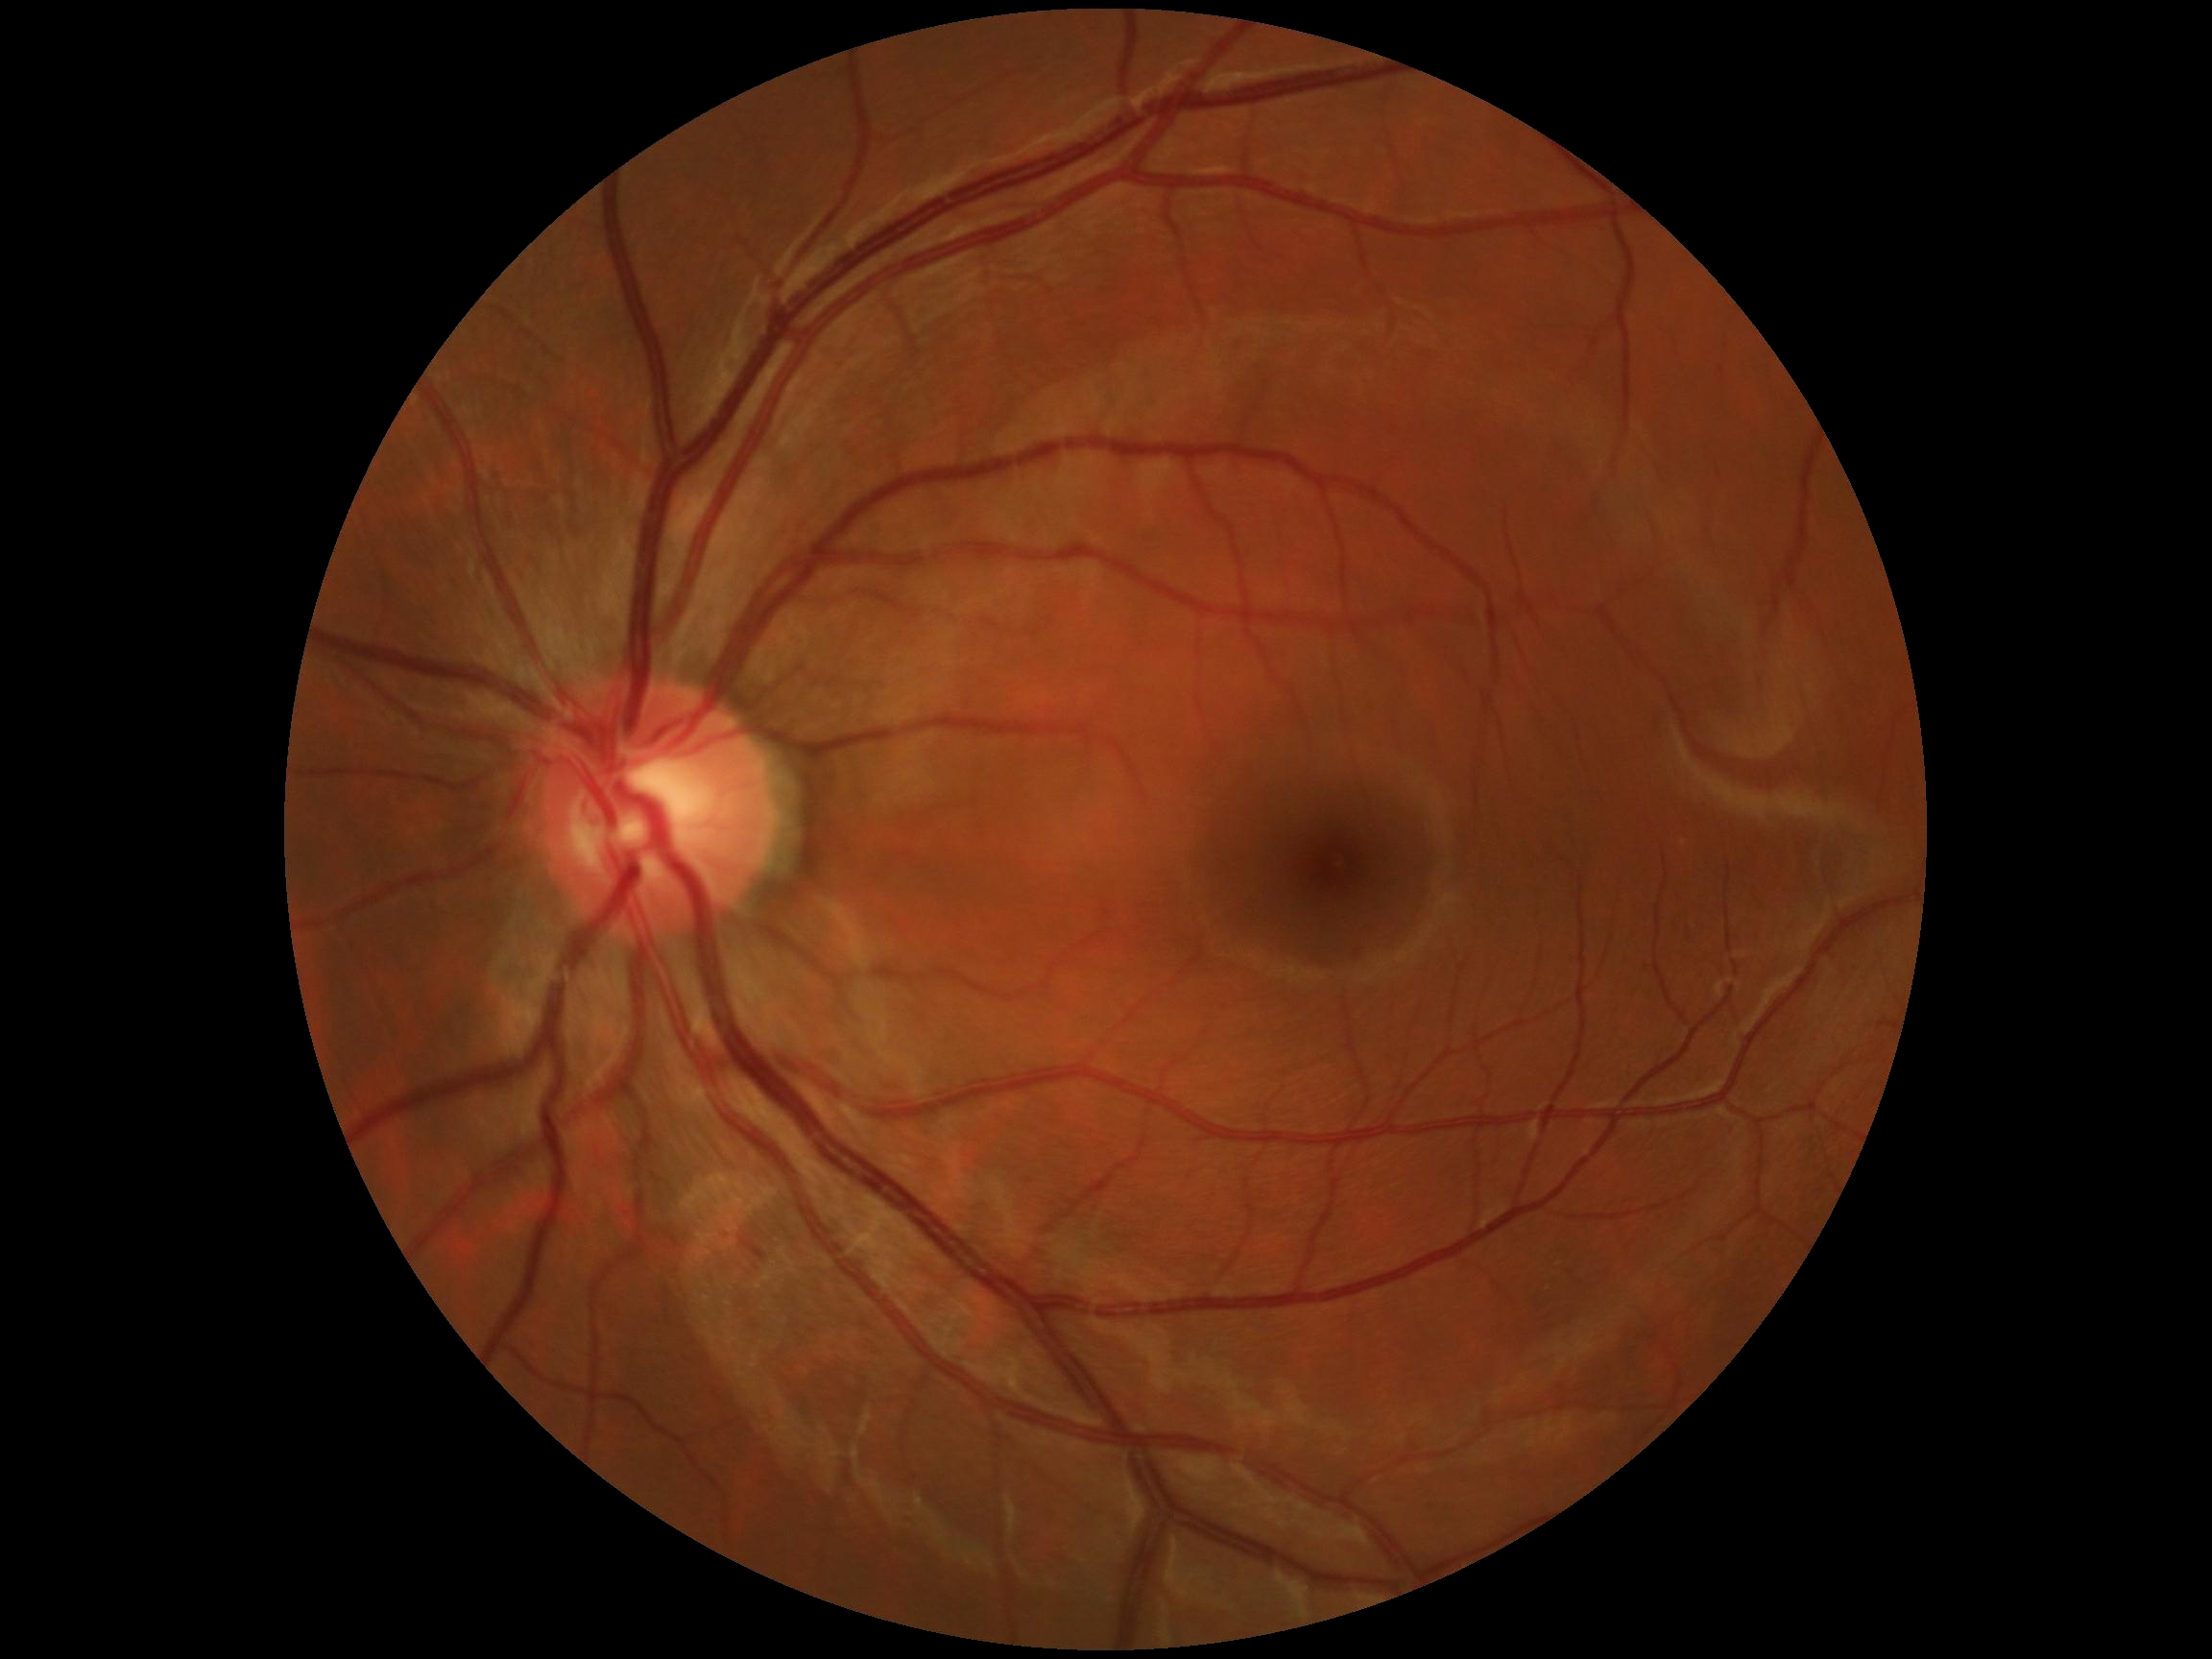 No DR findings. Diabetic retinopathy (DR): grade 0 — no visible signs of diabetic retinopathy.